Wide-field contact fundus photograph of an infant; captured with the Phoenix ICON (100° field of view).
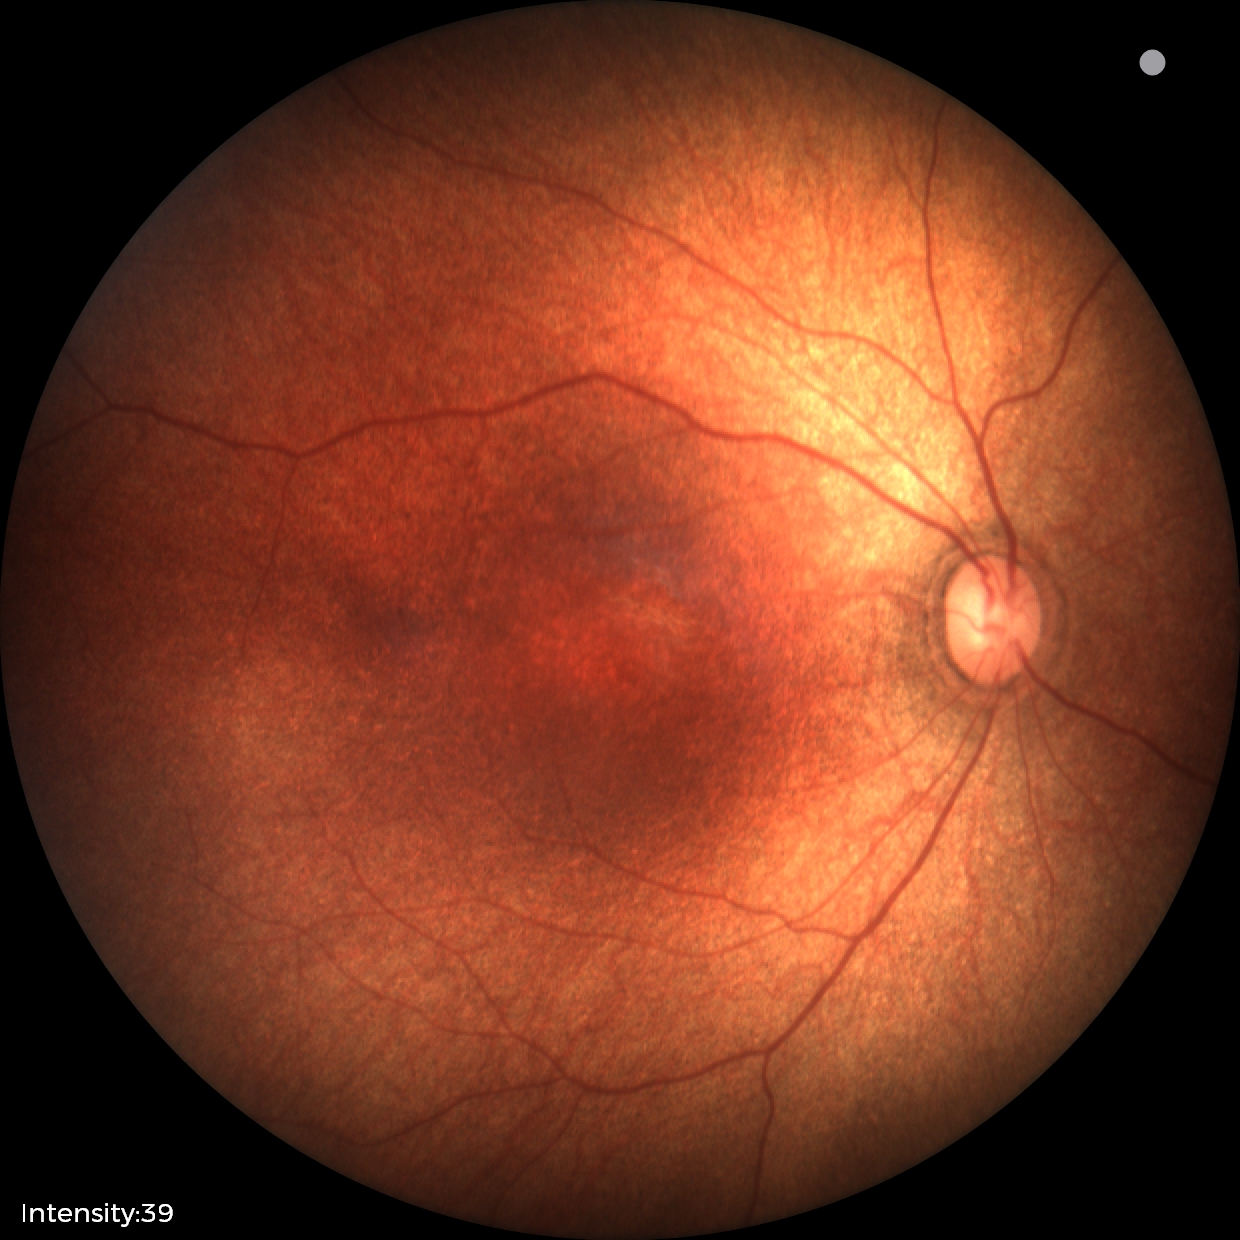

Q: What was the screening finding?
A: no abnormal retinal findings